Camera: NIDEK AFC-230. 45° field of view. 848 x 848 pixels:
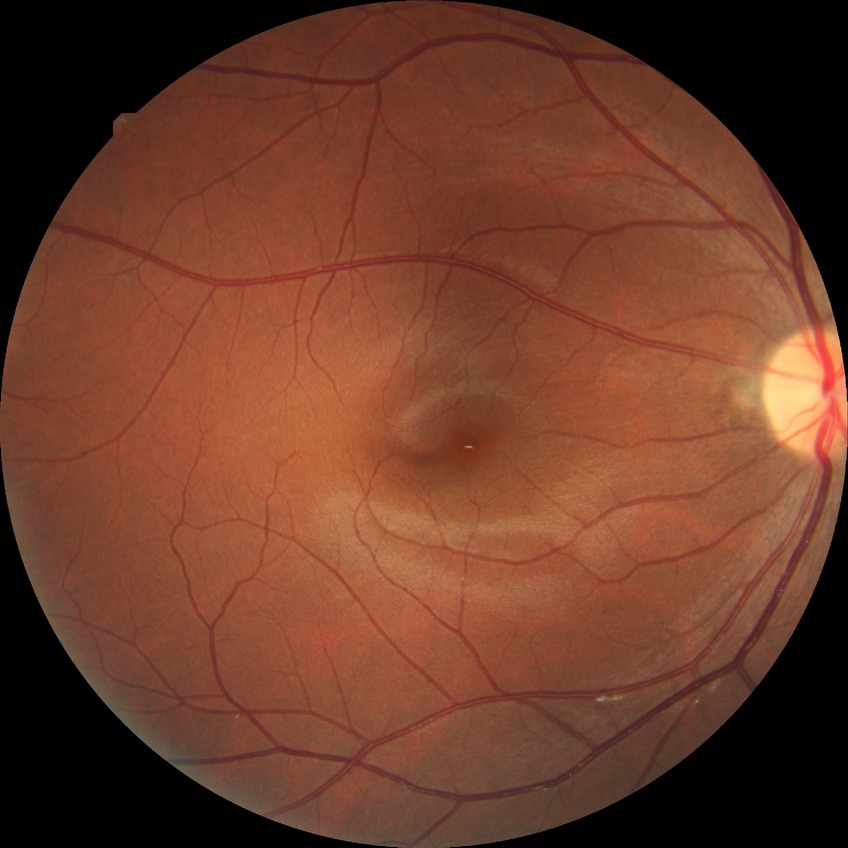
davis_grade: no diabetic retinopathy (NDR)